Infant wide-field fundus photograph · 640 x 480 pixels — 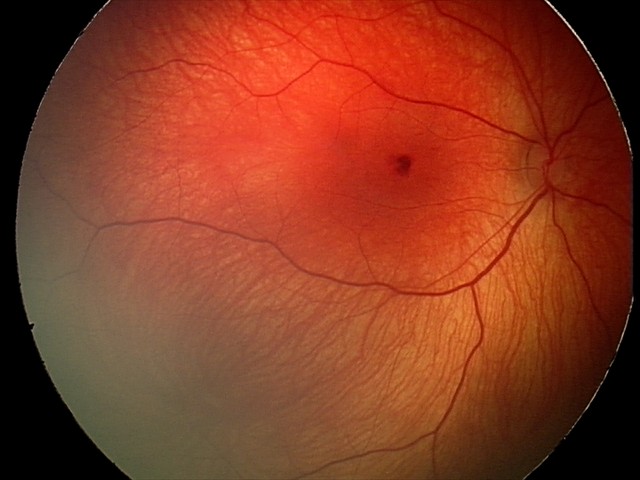
Screening series with retinal hemorrhages.